Clarity RetCam 3, 130° FOV; RetCam wide-field infant fundus image; 640x480:
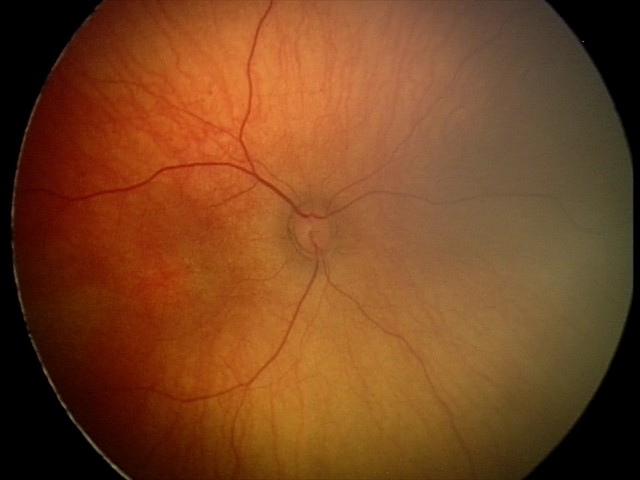

Impression: normal retinal appearance